1440 by 1080 pixels. Infant wide-field retinal image:
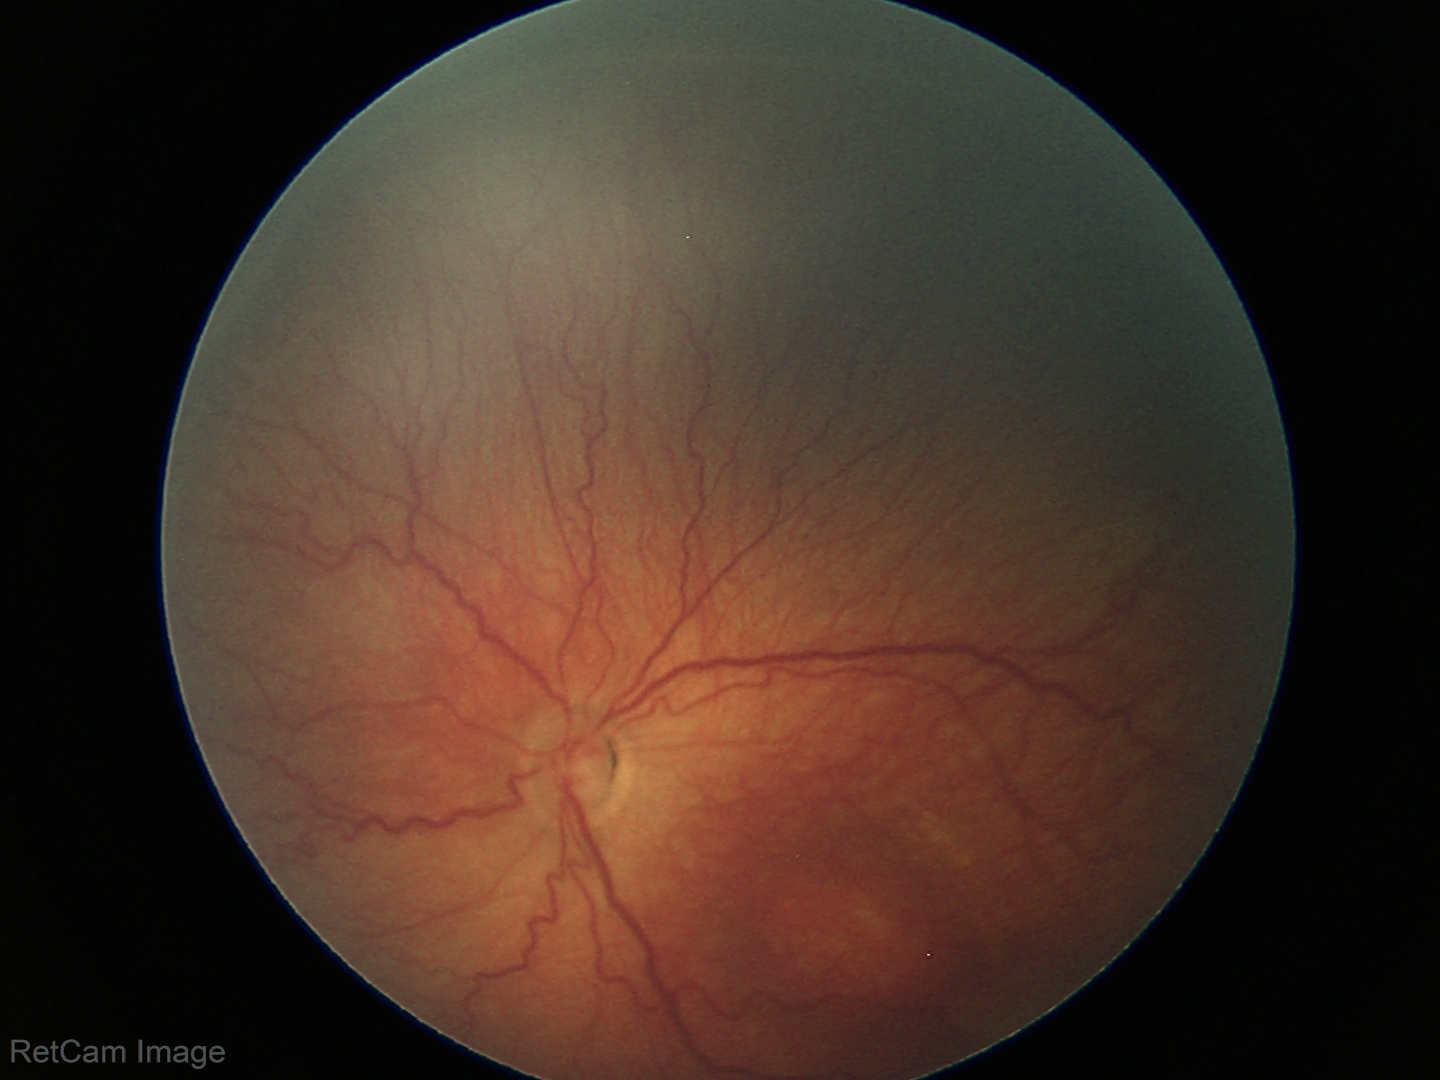

ROP = stage 3, plus form = absent.